Diabetic retinopathy graded by the modified Davis classification; 45° FOV:
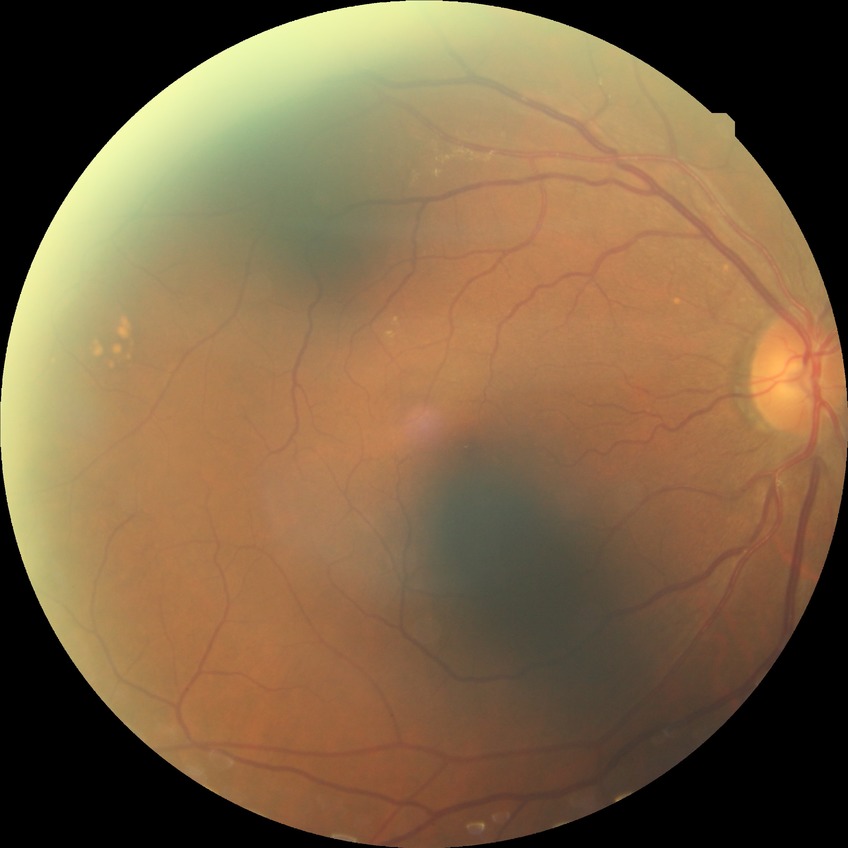
Diabetic retinopathy (DR) is NDR (no diabetic retinopathy).